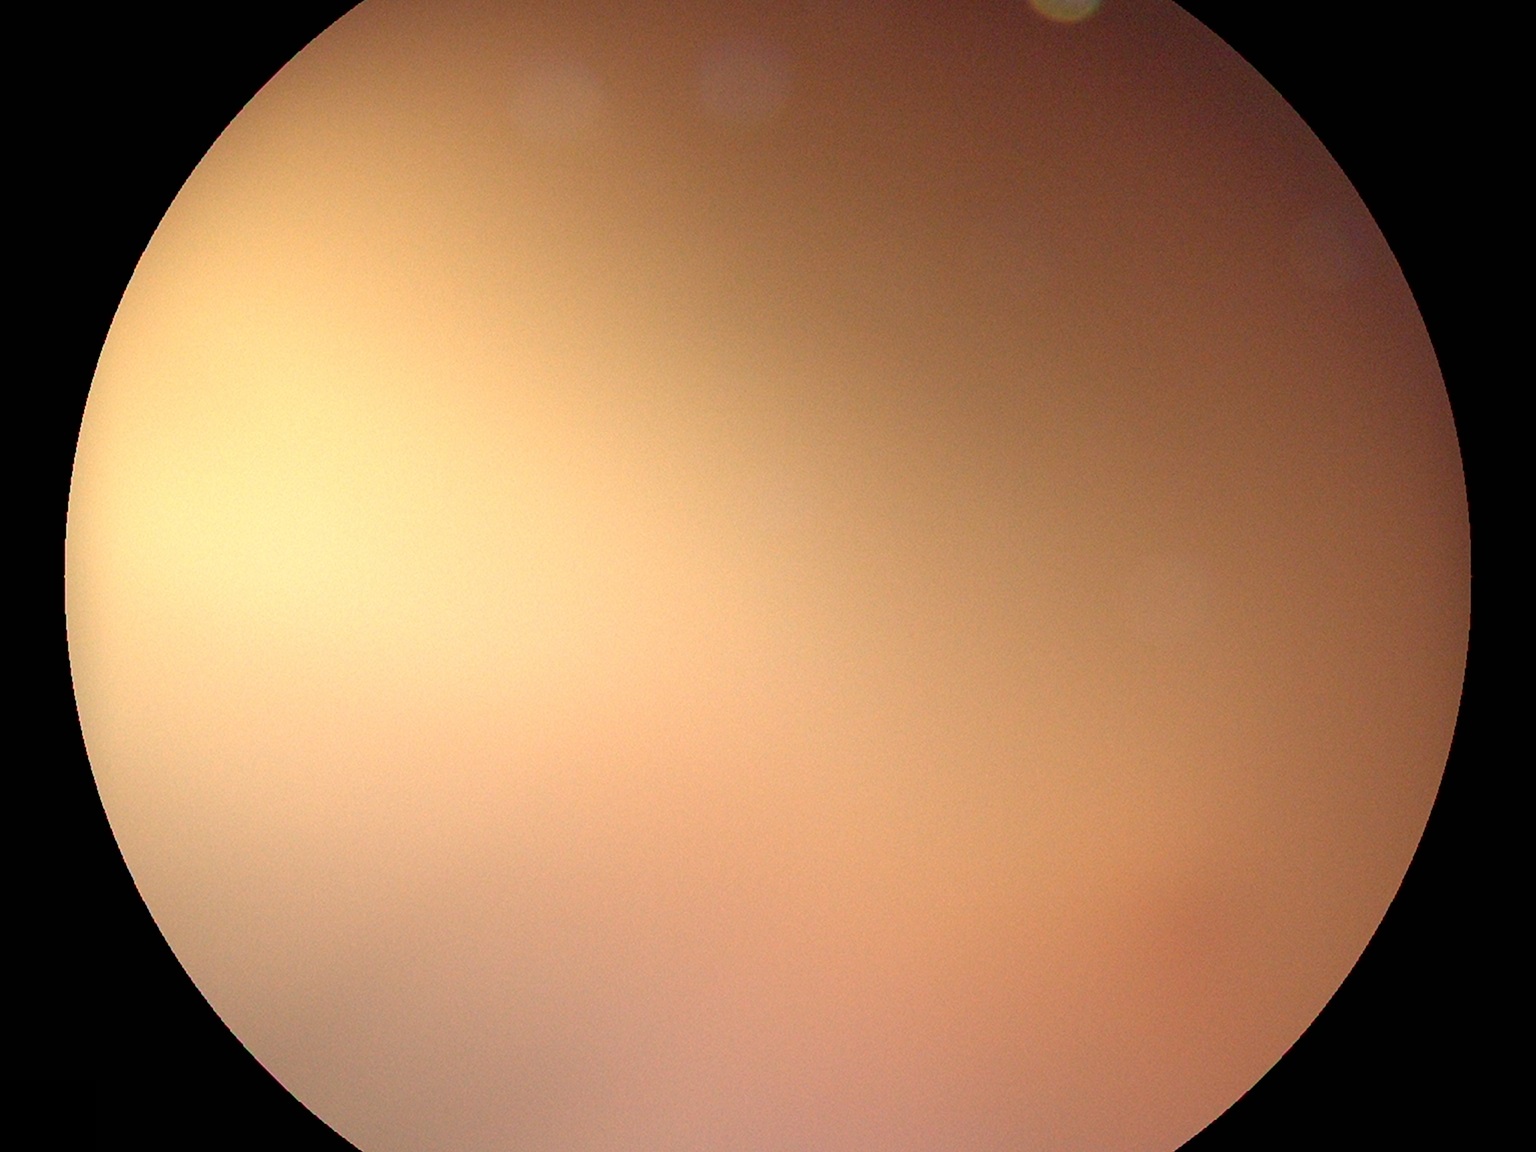

Quality too poor to assess for DR.
Diabetic retinopathy severity: ungradable.